FOV: 45 degrees. Color fundus photograph. Image size 1932x1910: 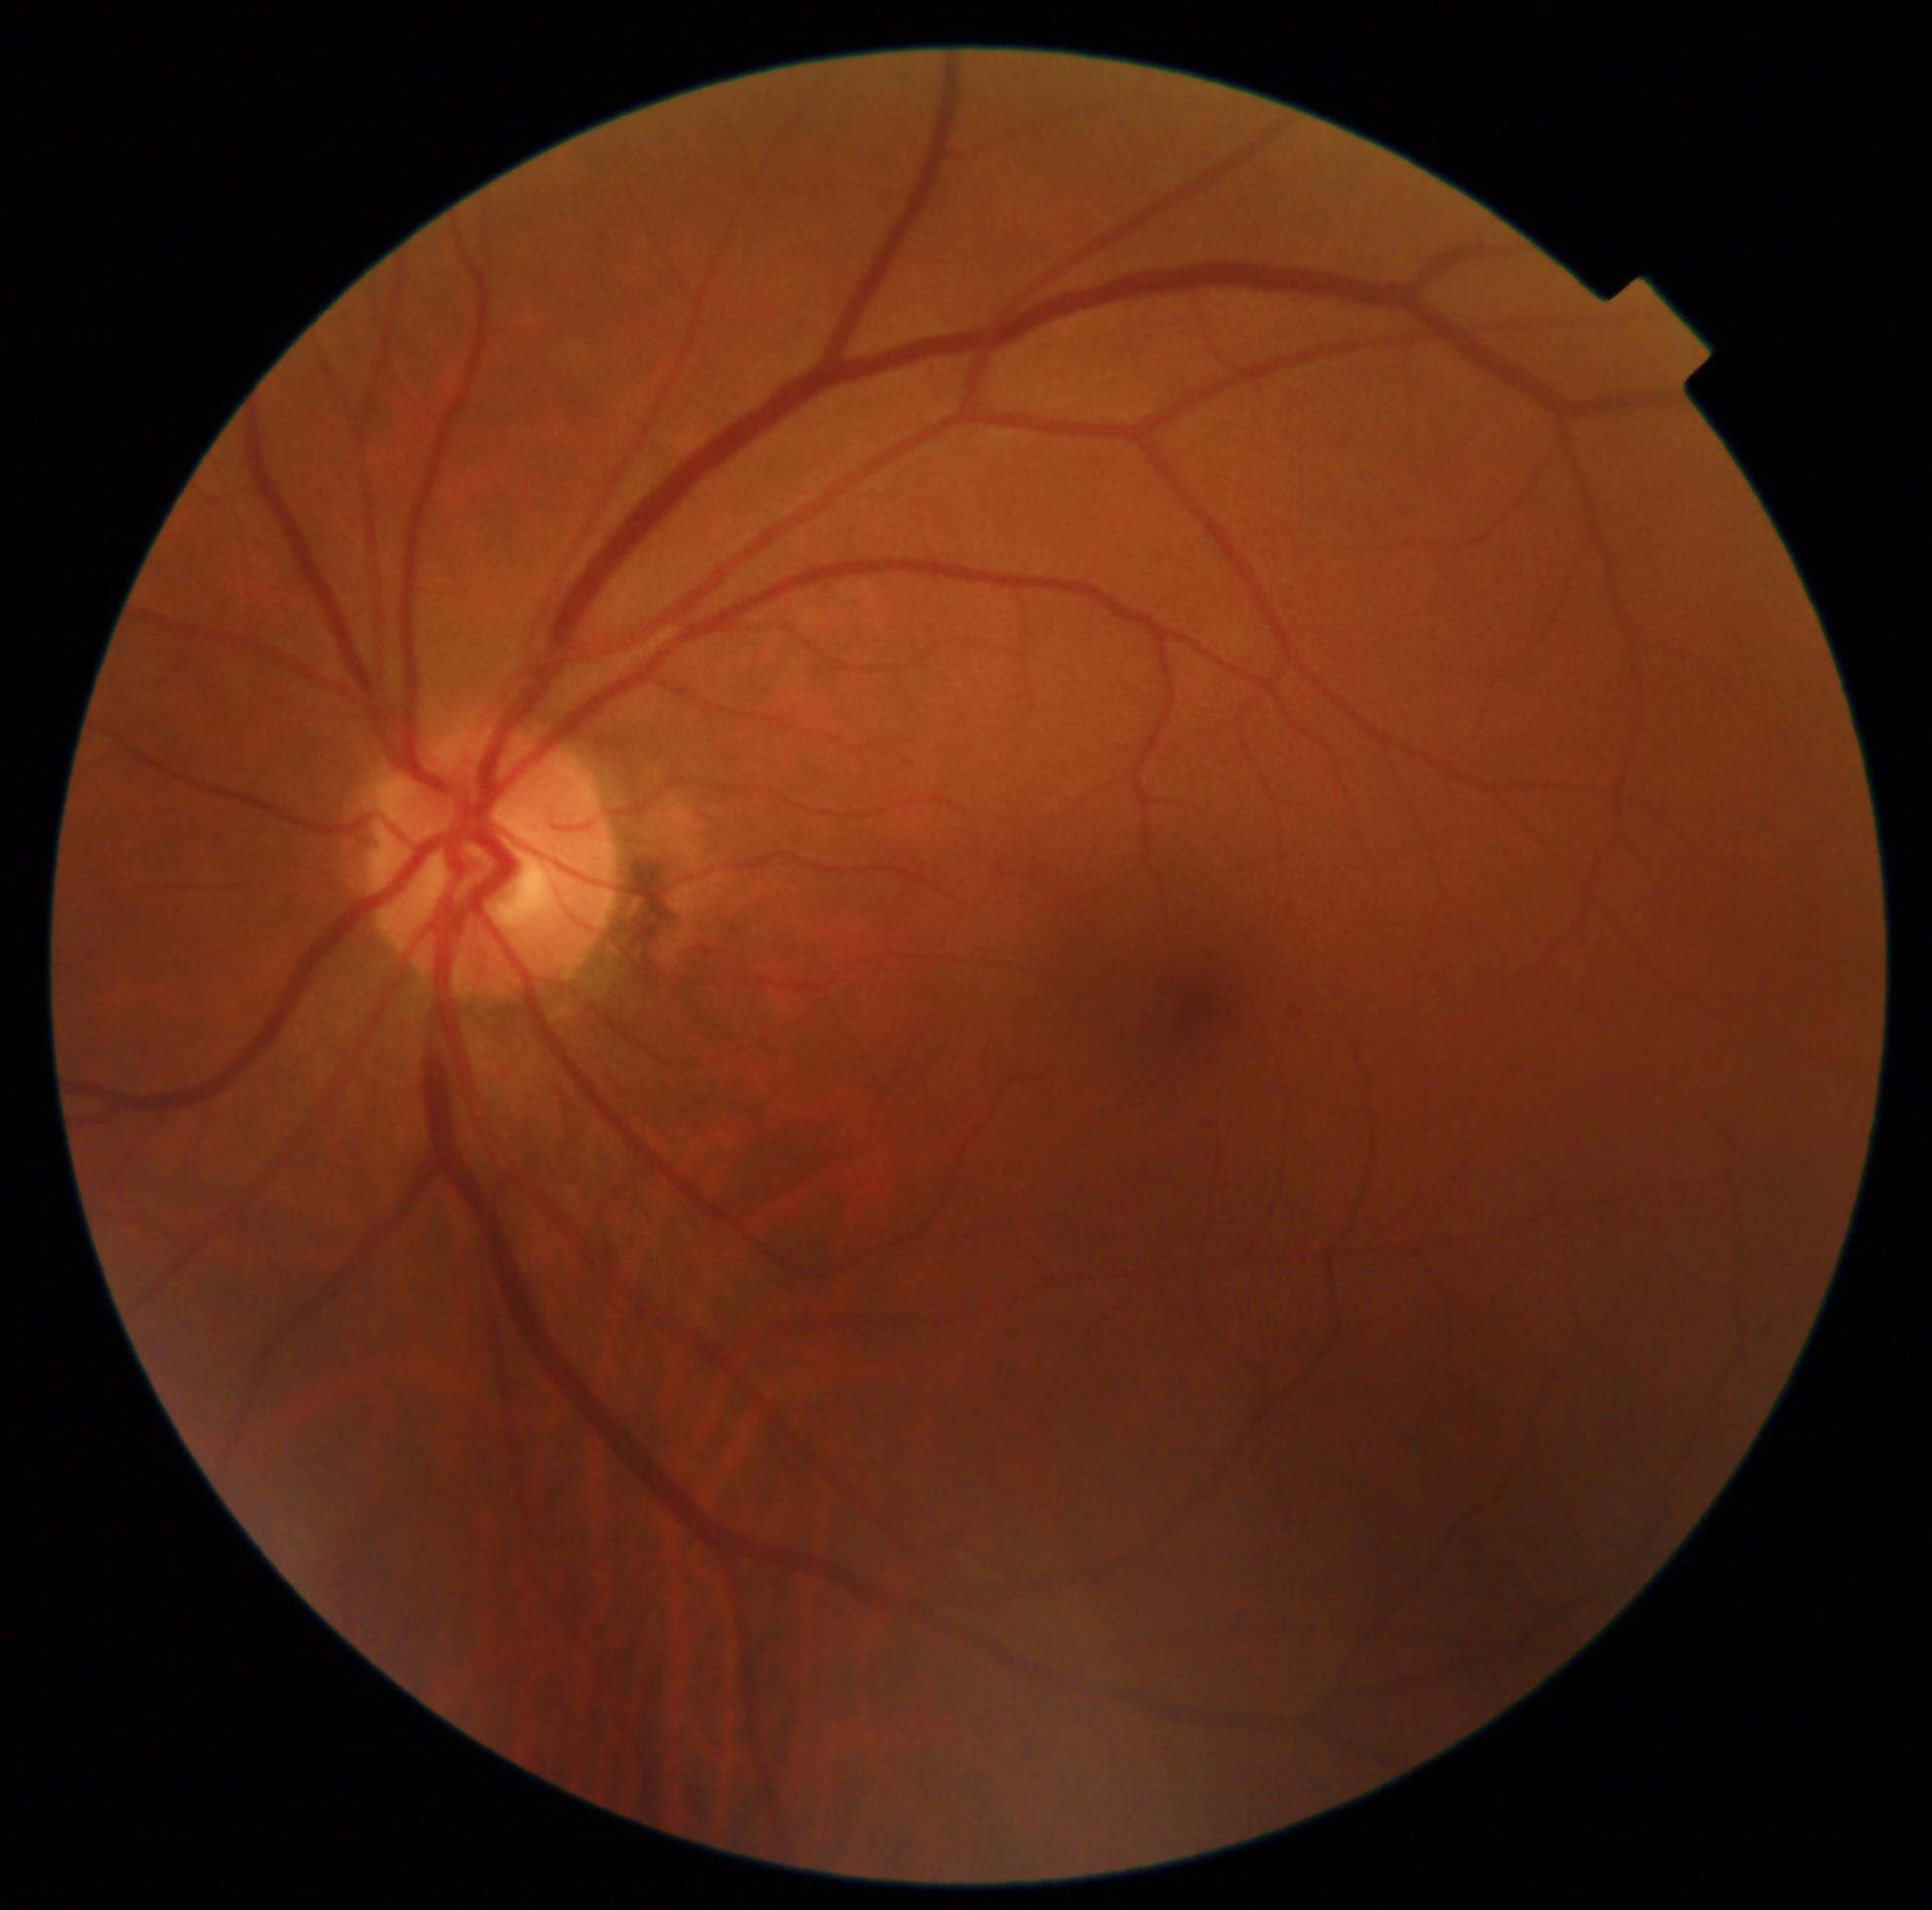

{"dr_grade": "1/4"}